640x480. RetCam wide-field infant fundus image:
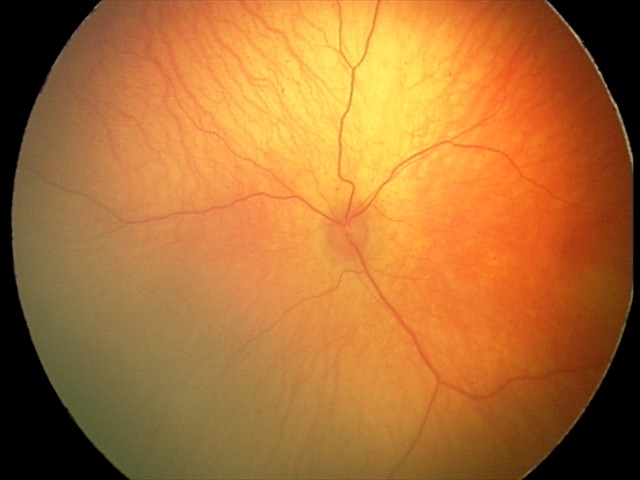
Physiological retinal appearance for postconceptual age.